Phoenix ICON wide-field infant fundus image: 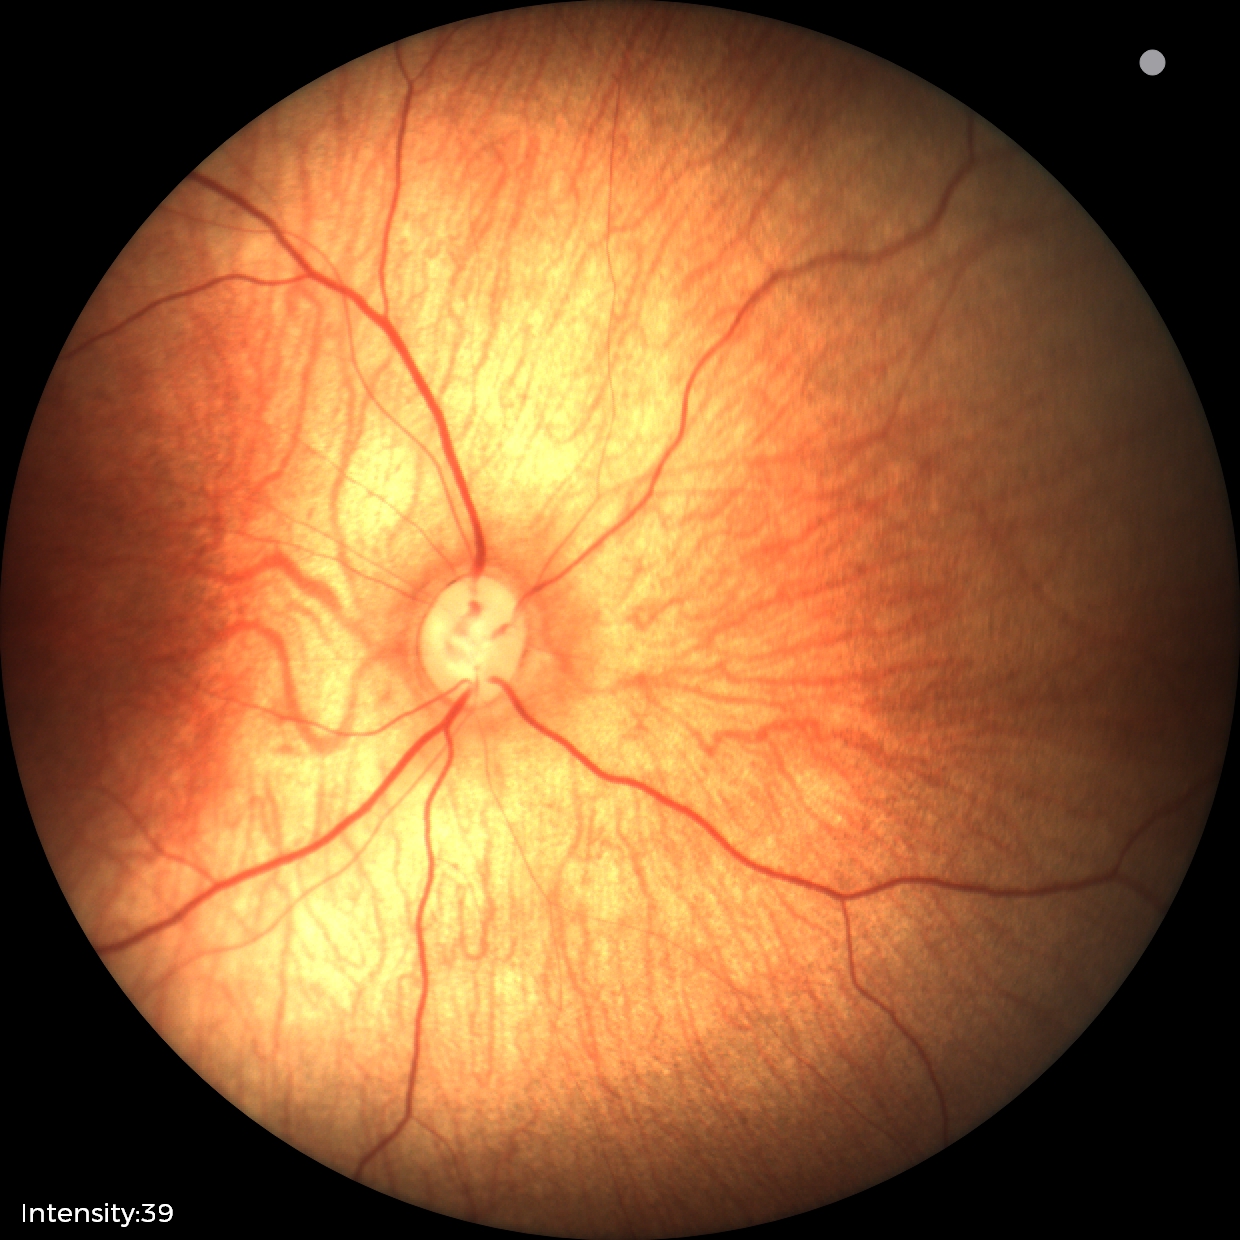

Physiological retinal appearance for postconceptual age.